FOV: 45 degrees:
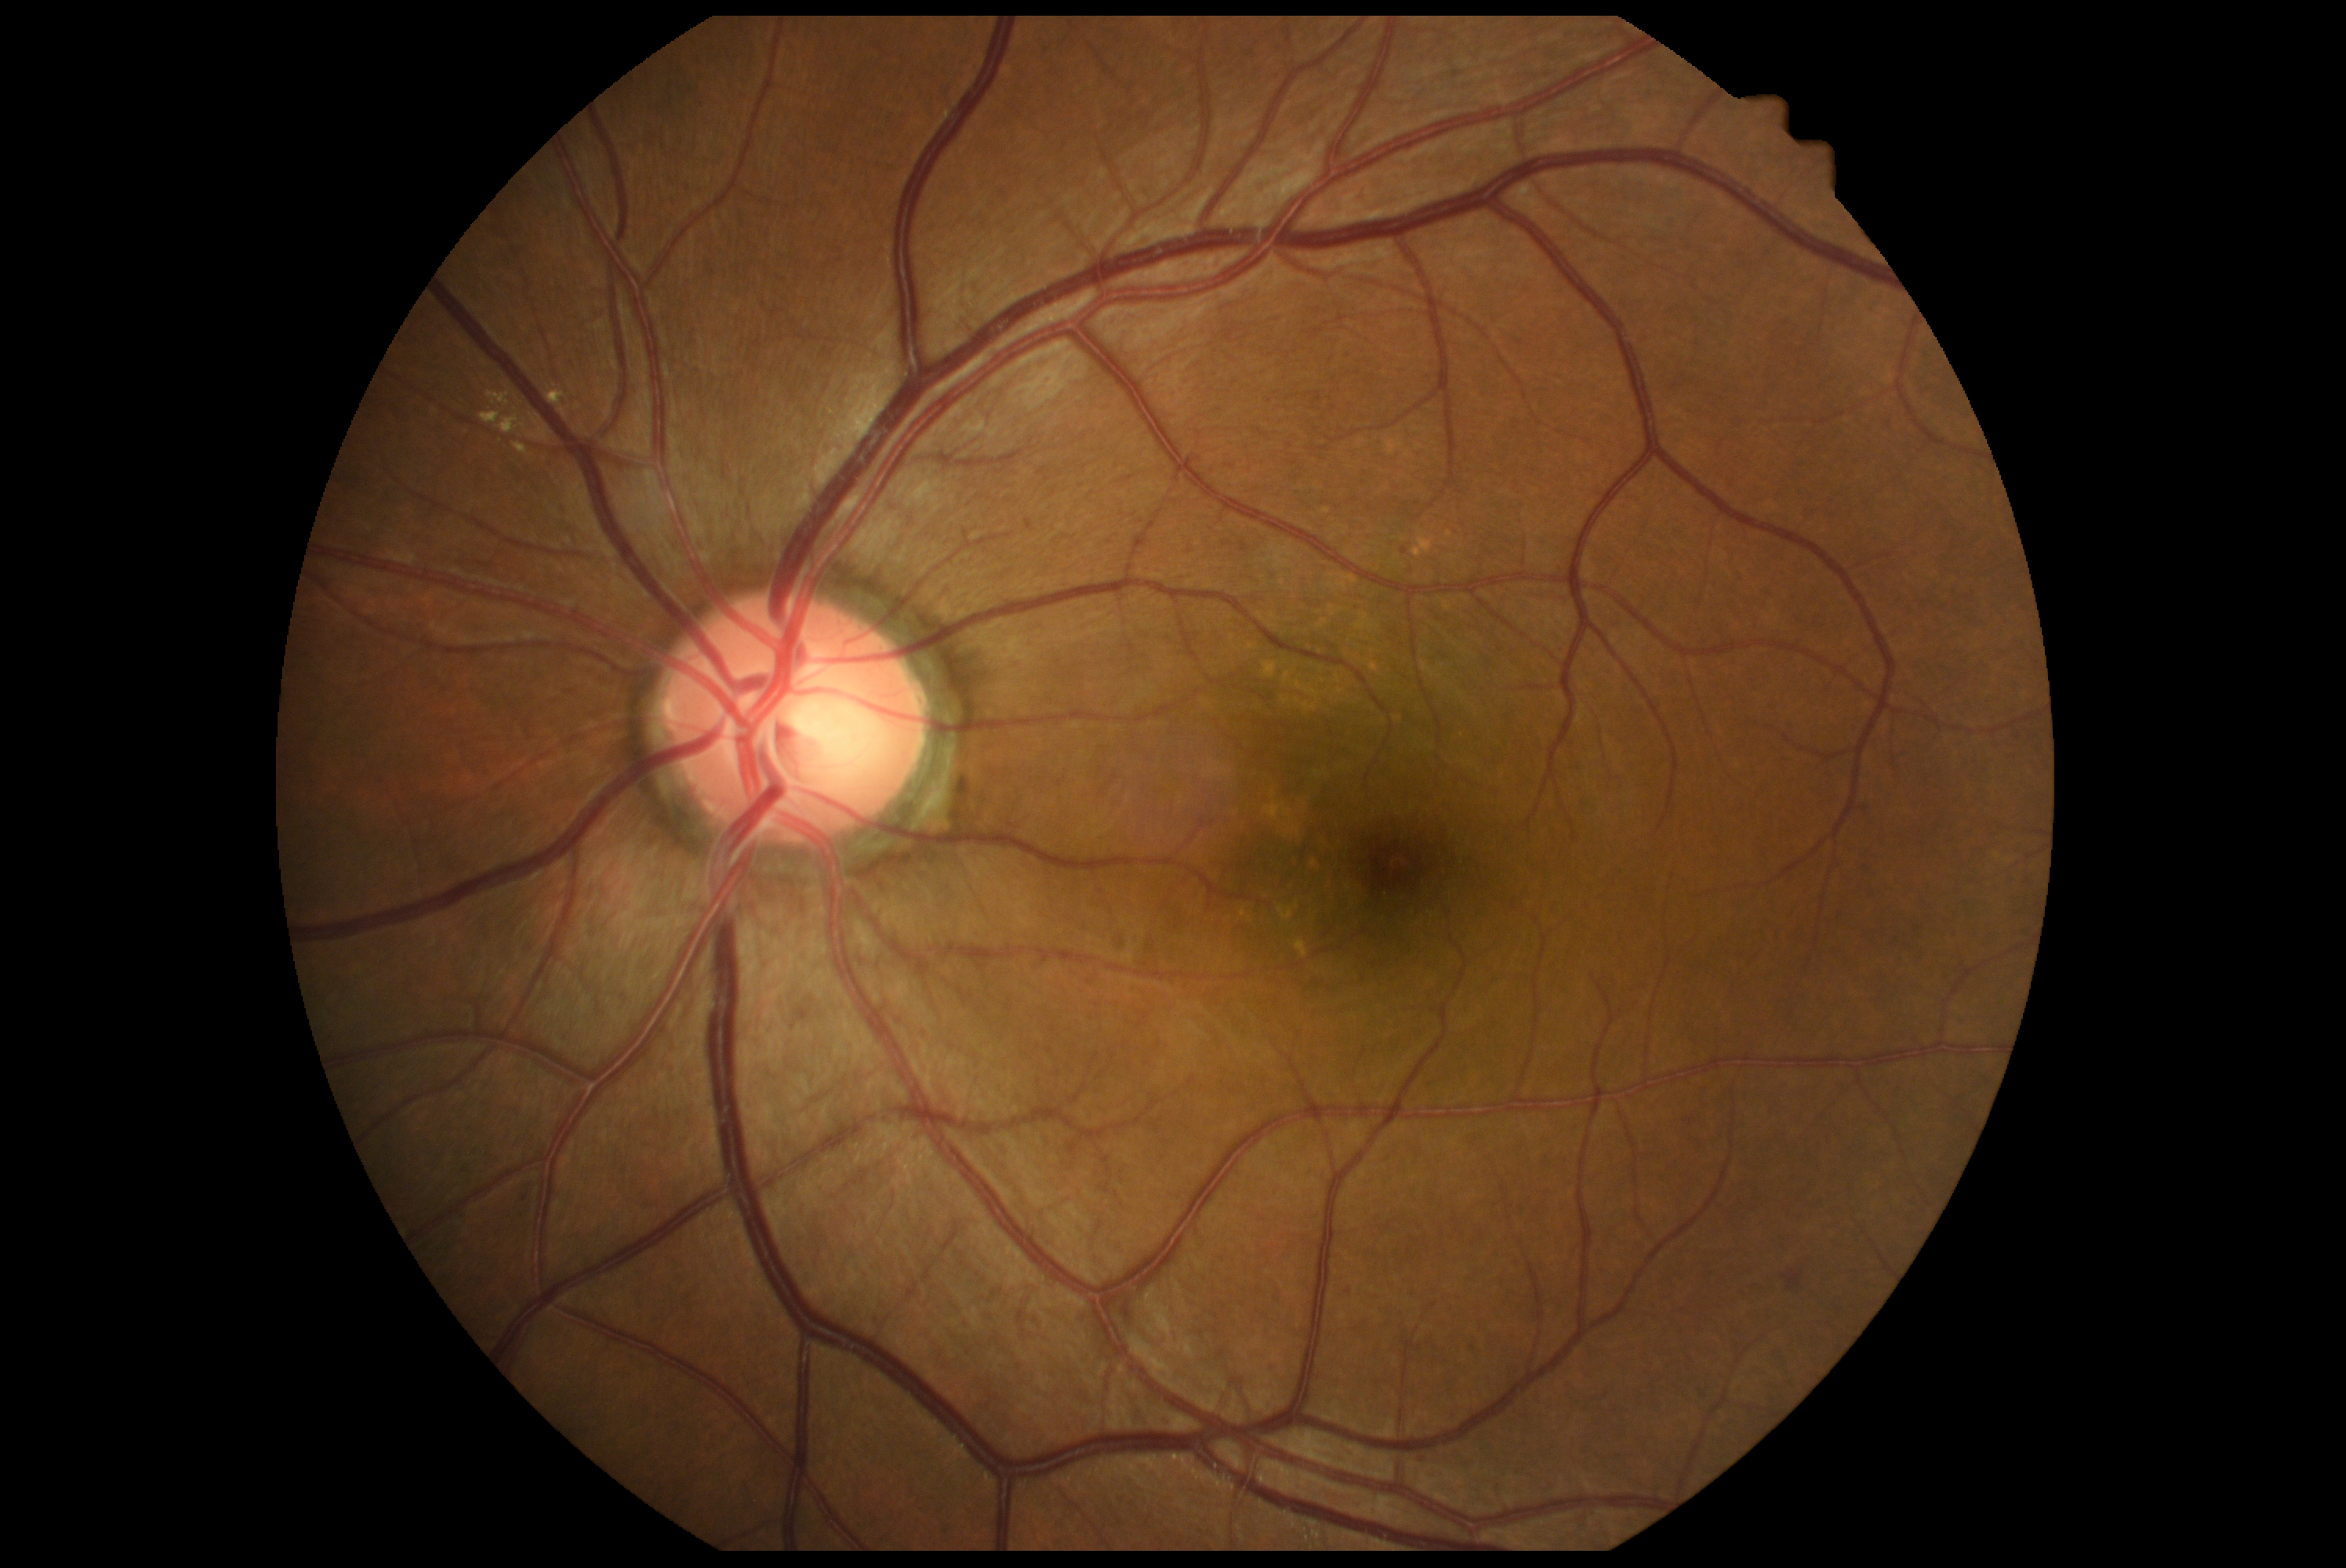

DR grade: 2/4 — more than just microaneurysms but less than severe NPDR.